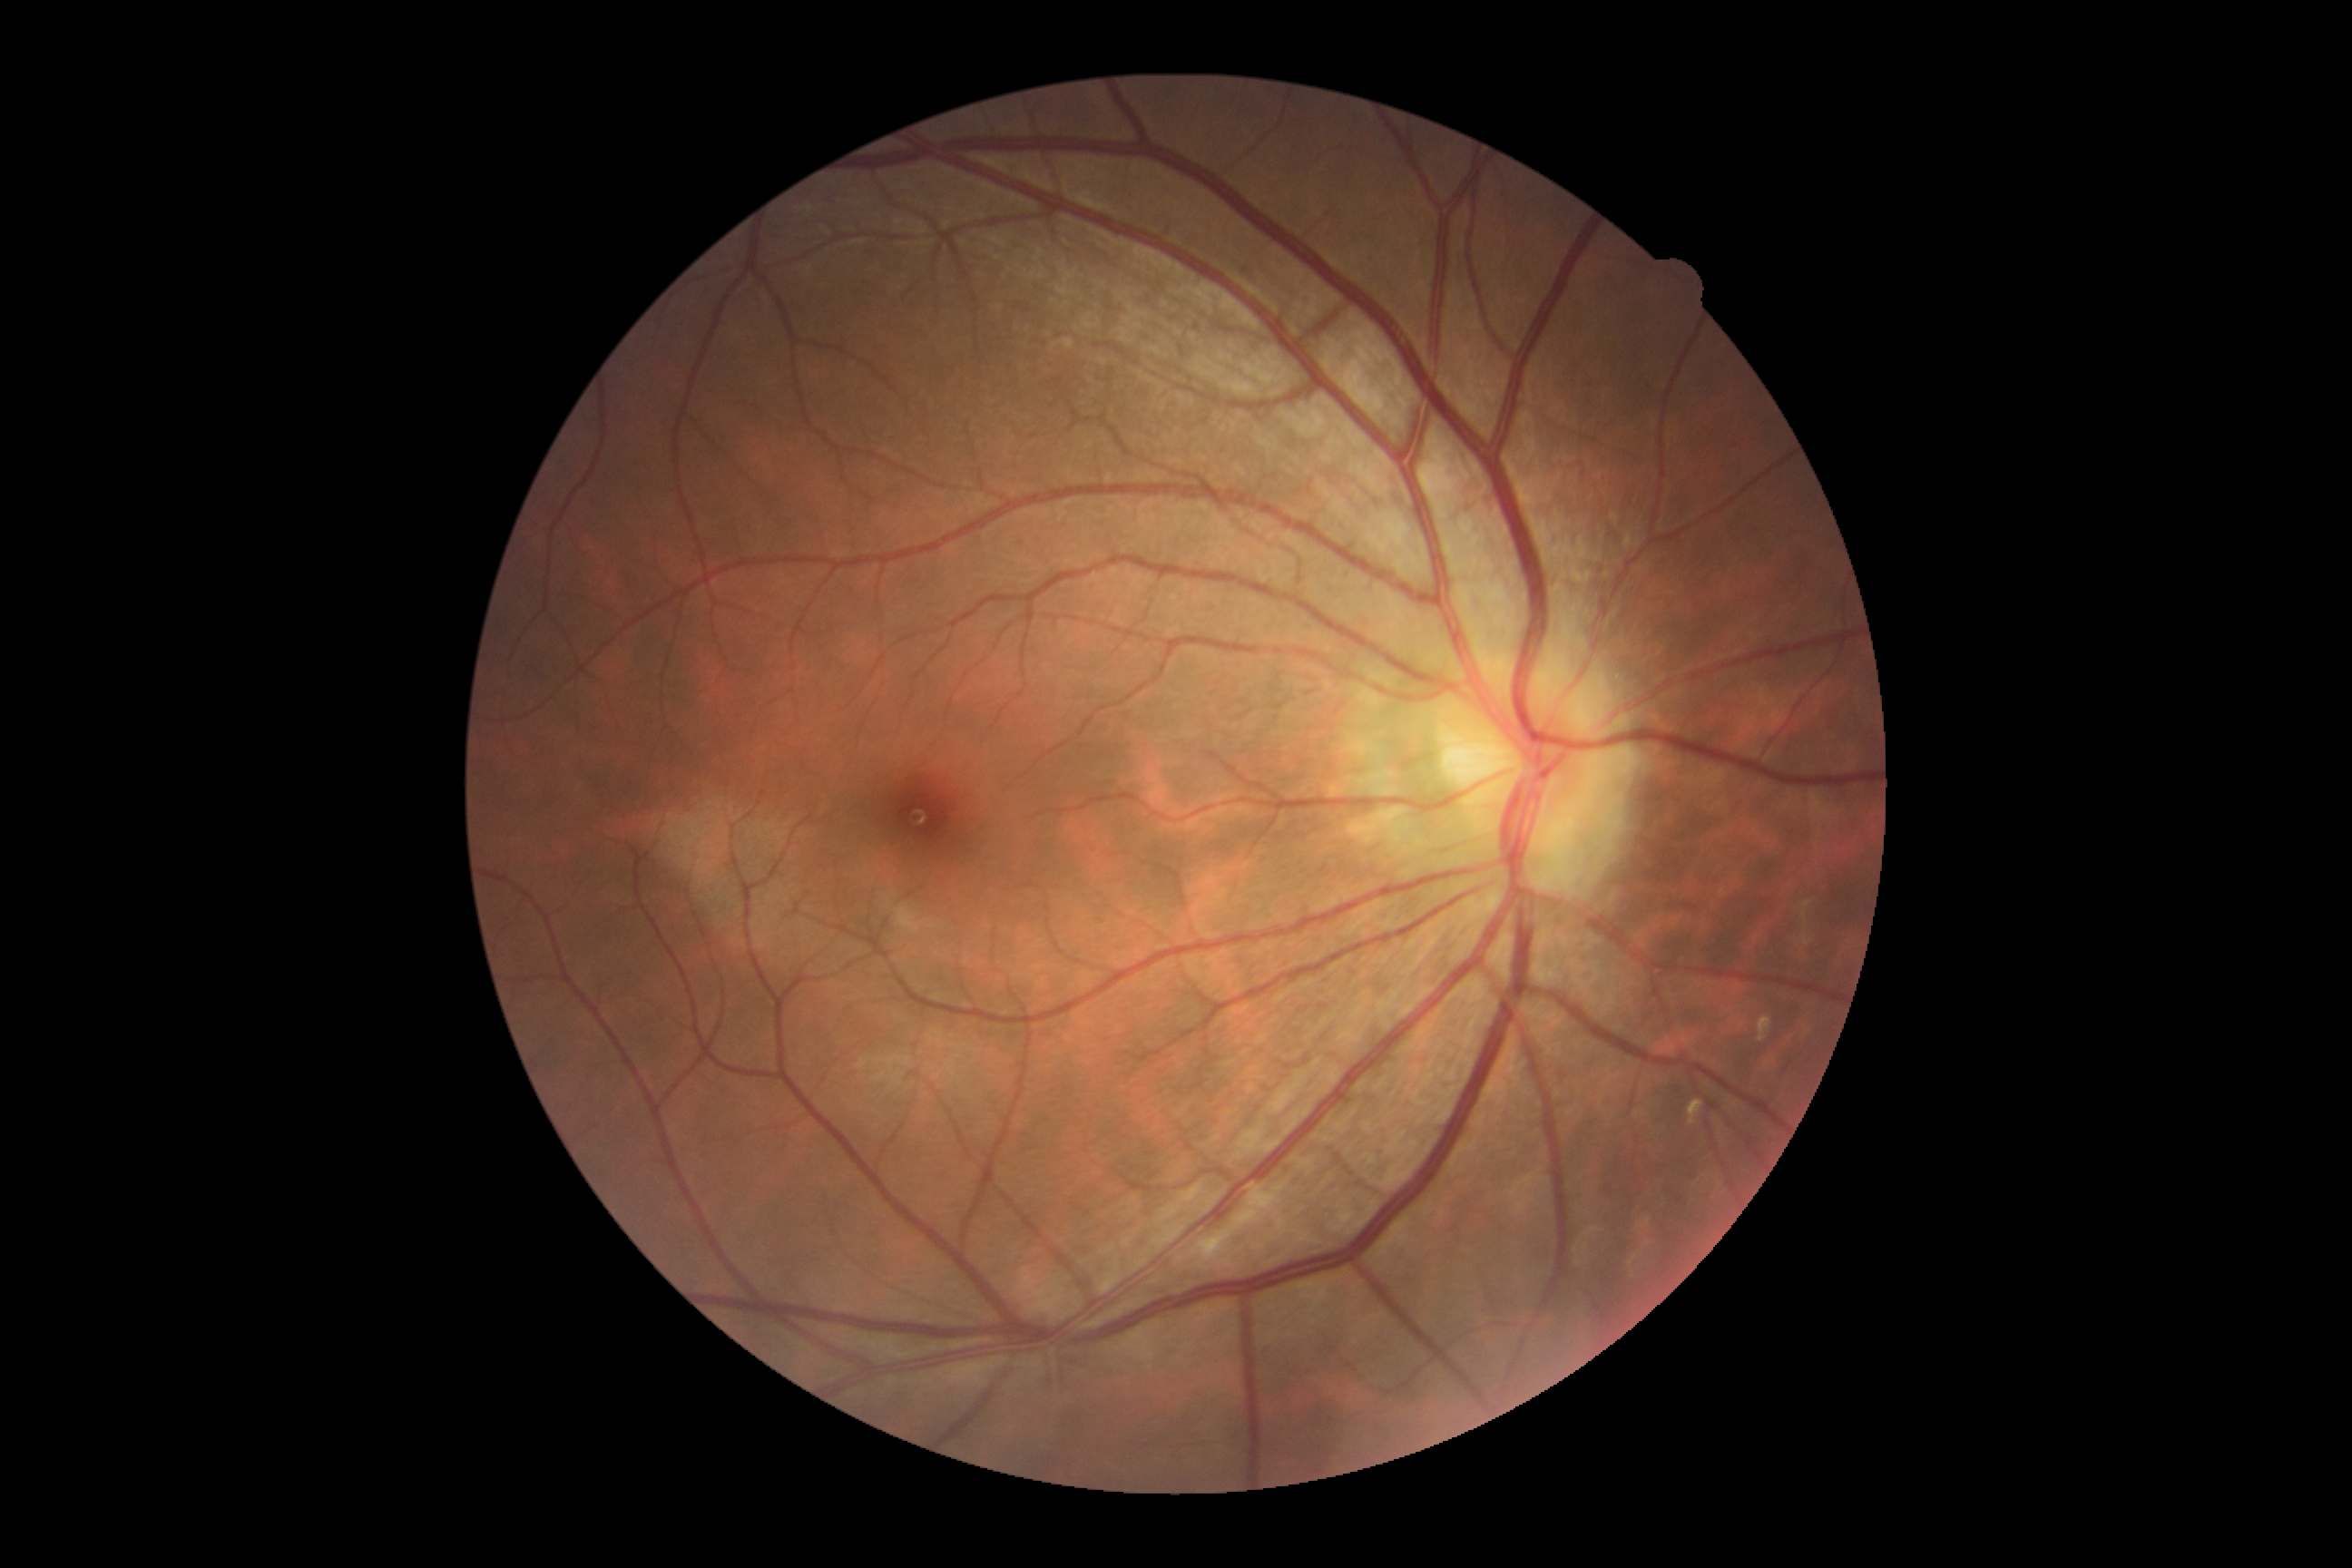

dr_grade: 0